Color fundus image · 1534x1534px · 50° FOV — 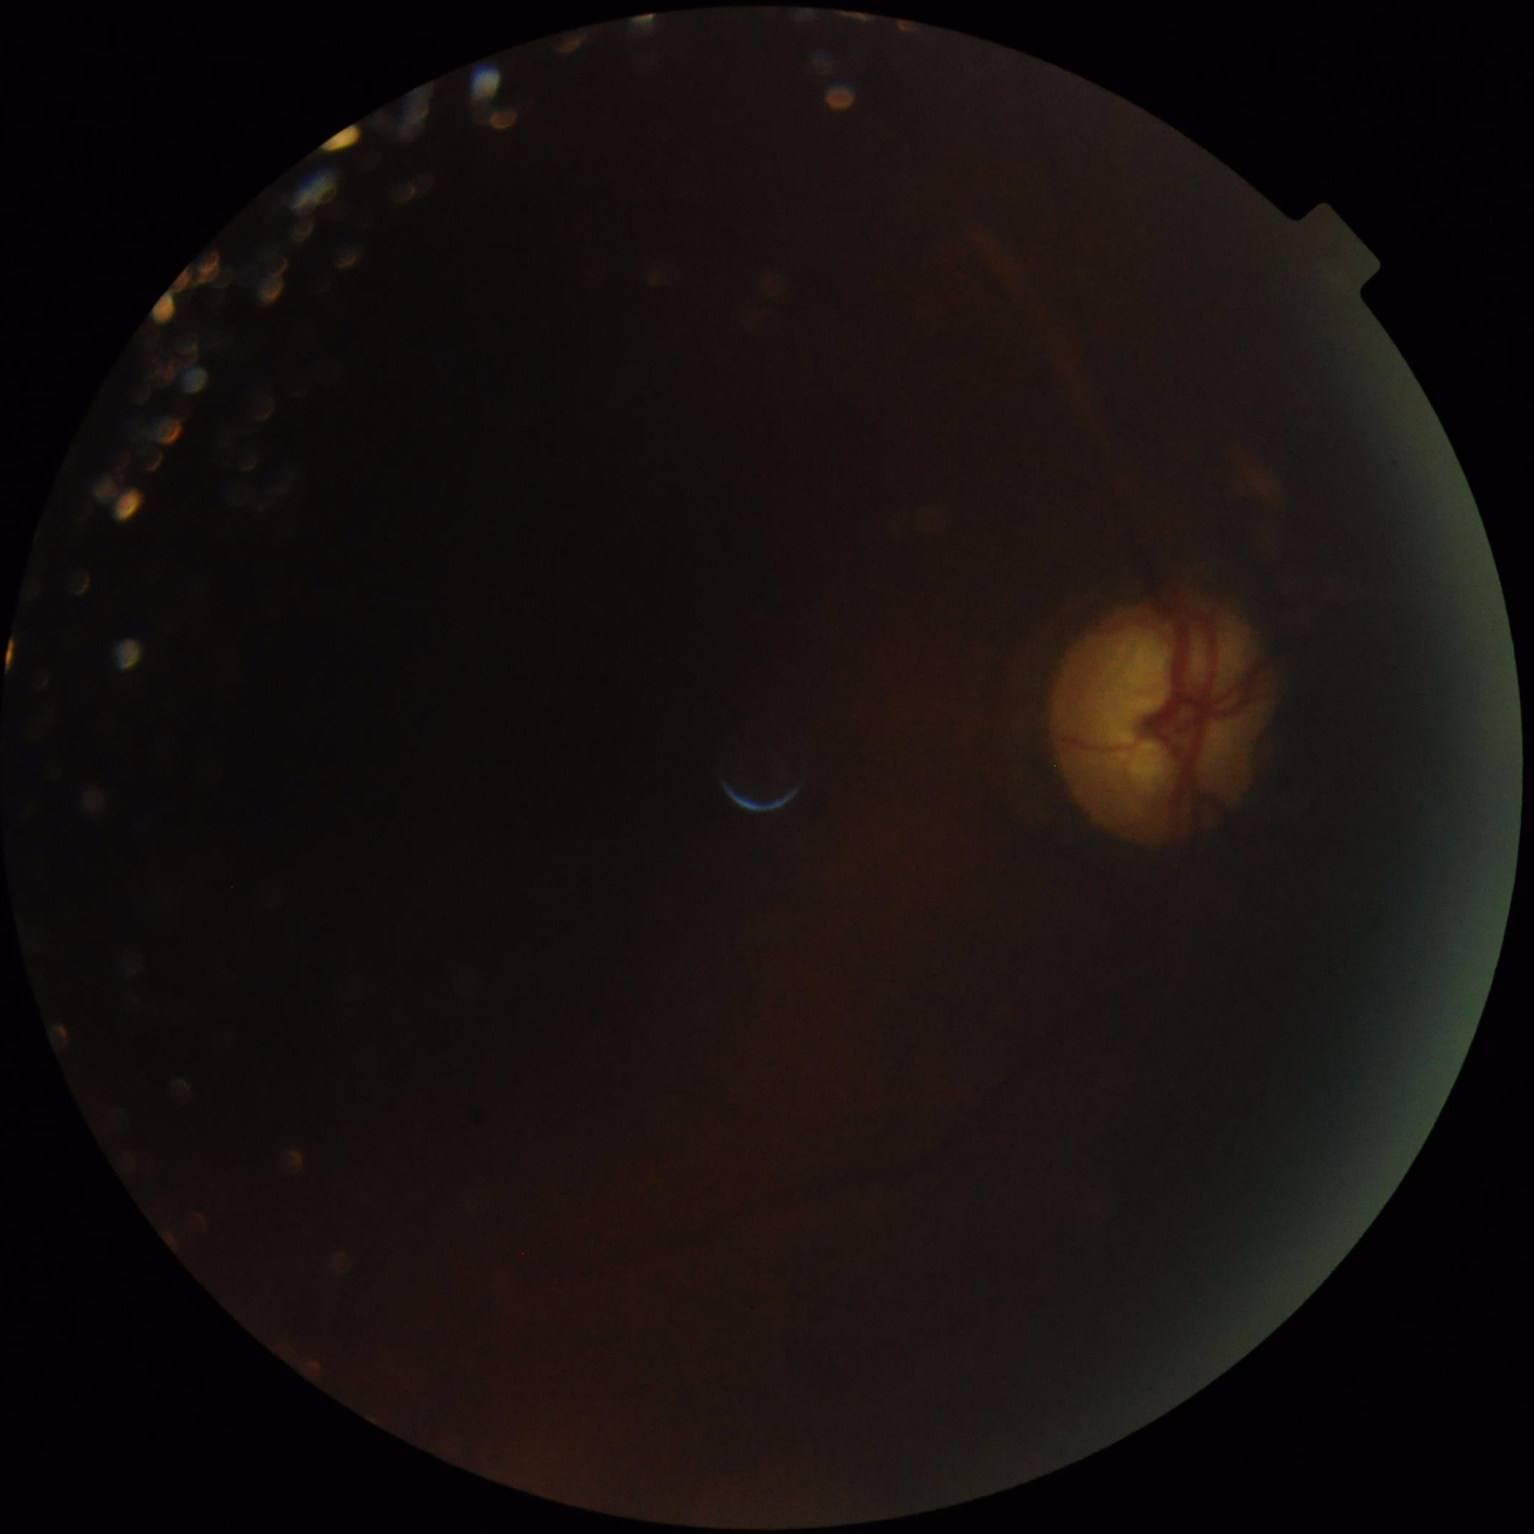 Poor illumination with uneven exposure.
Poor dynamic range.
Reduced sharpness with visible blur.
Image quality is suboptimal.